Phoenix ICON wide-field infant fundus image · camera: Phoenix ICON (100° FOV)
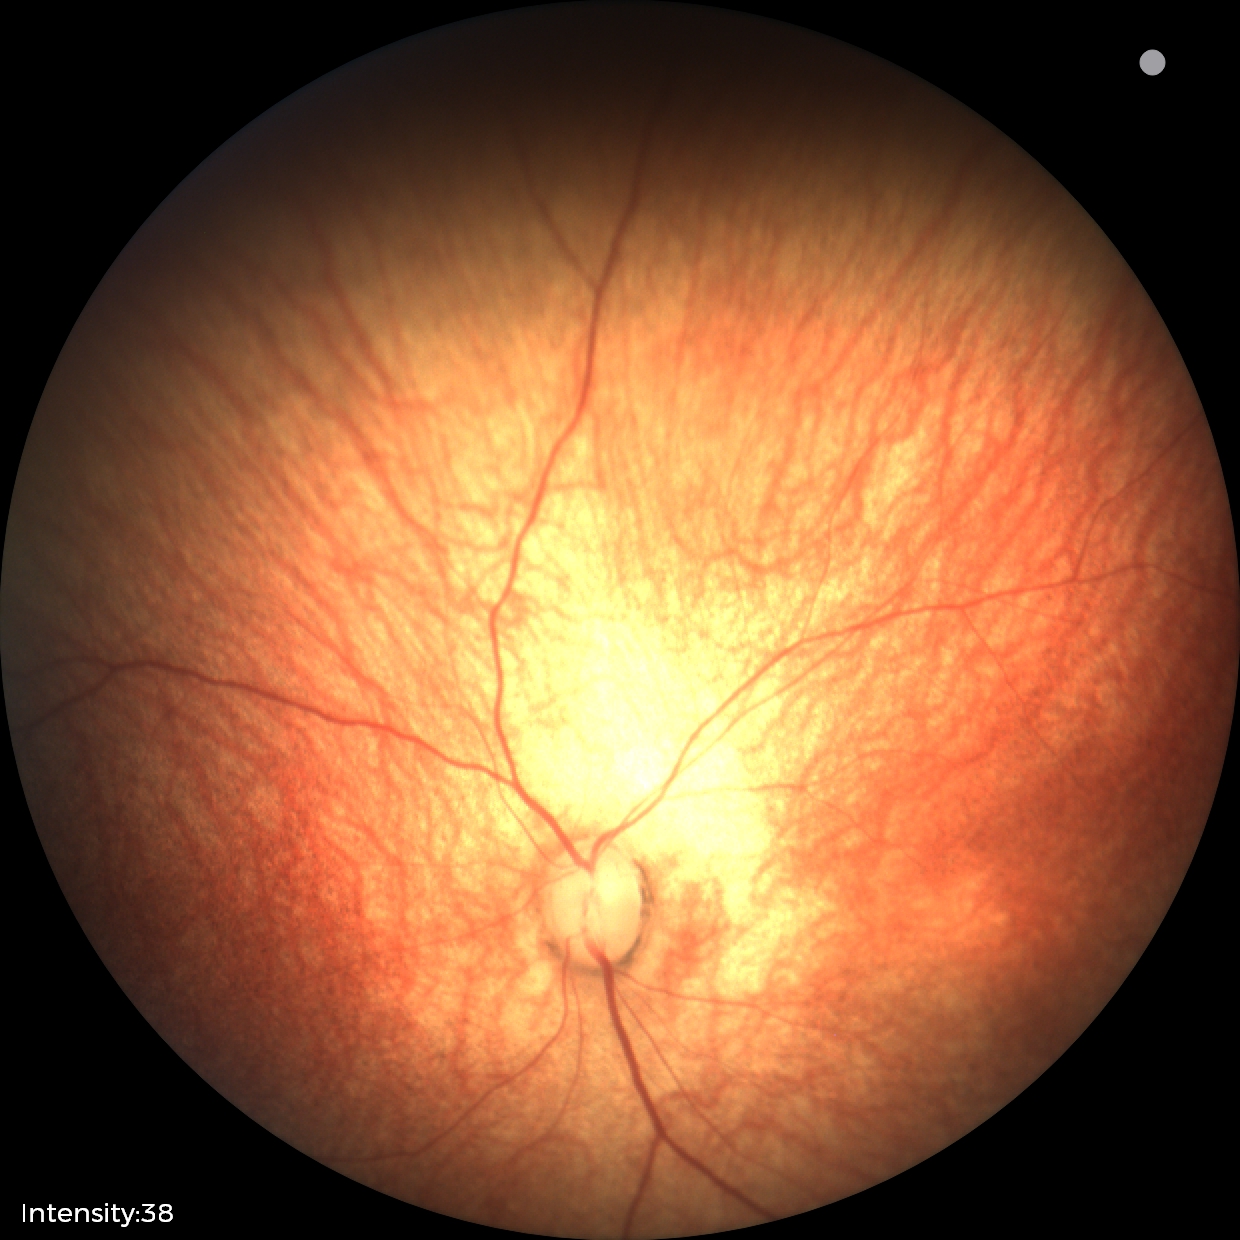
Screening: physiological appearance with no retinal pathology.